Wide-field fundus photograph from neonatal ROP screening — 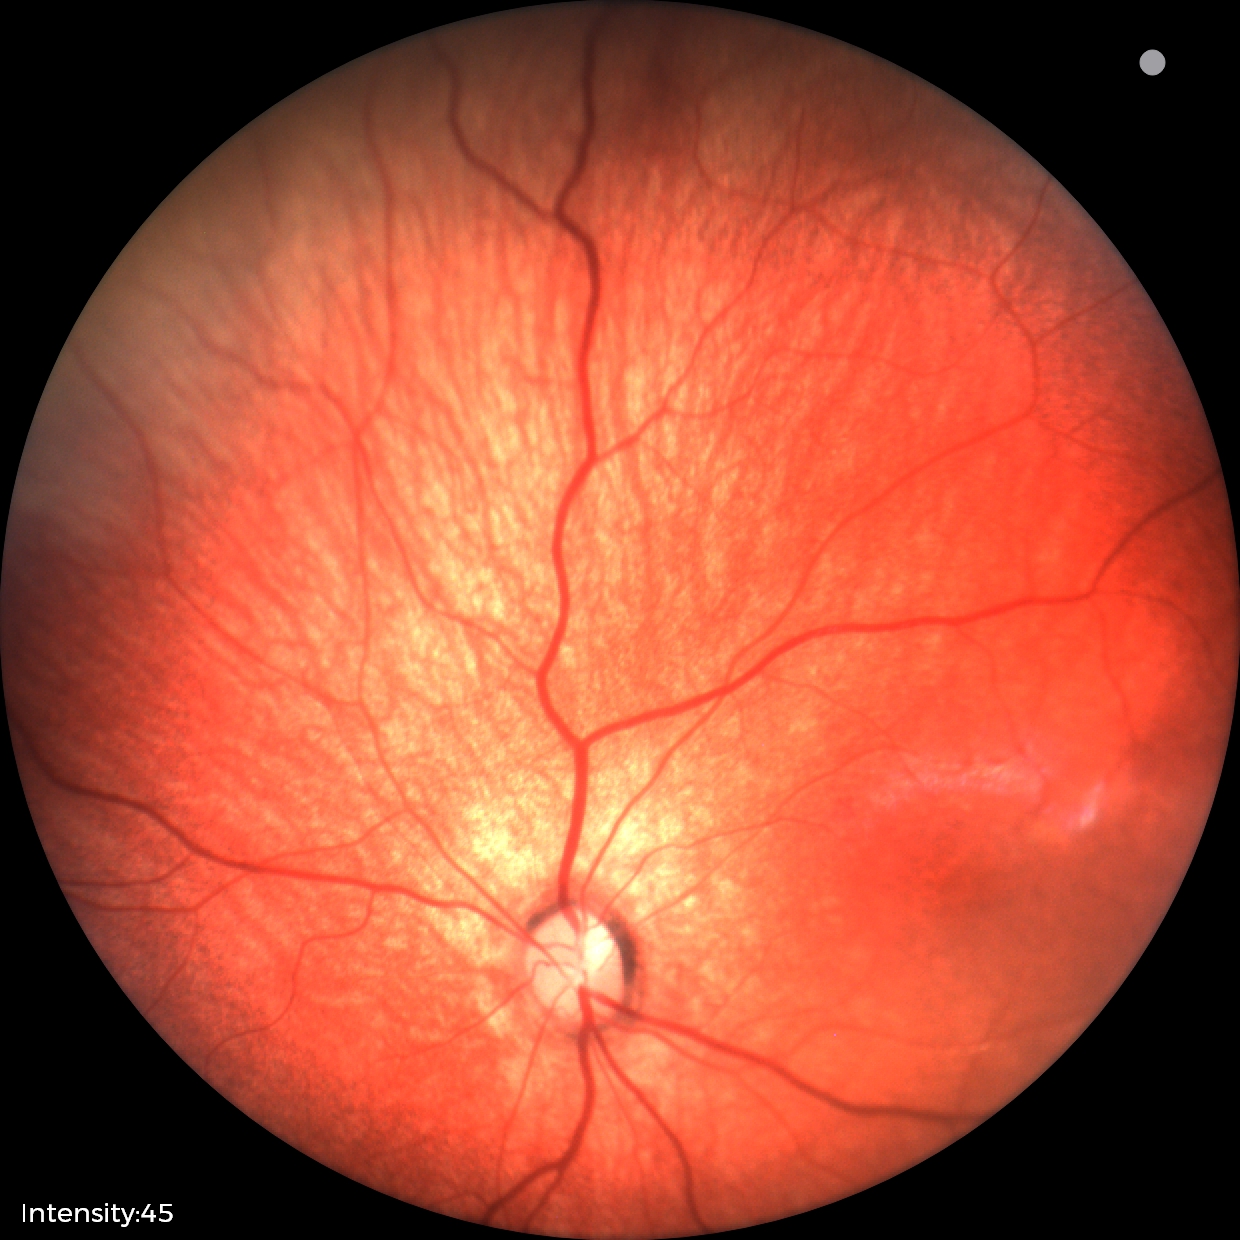

Impression: normal retinal appearance.